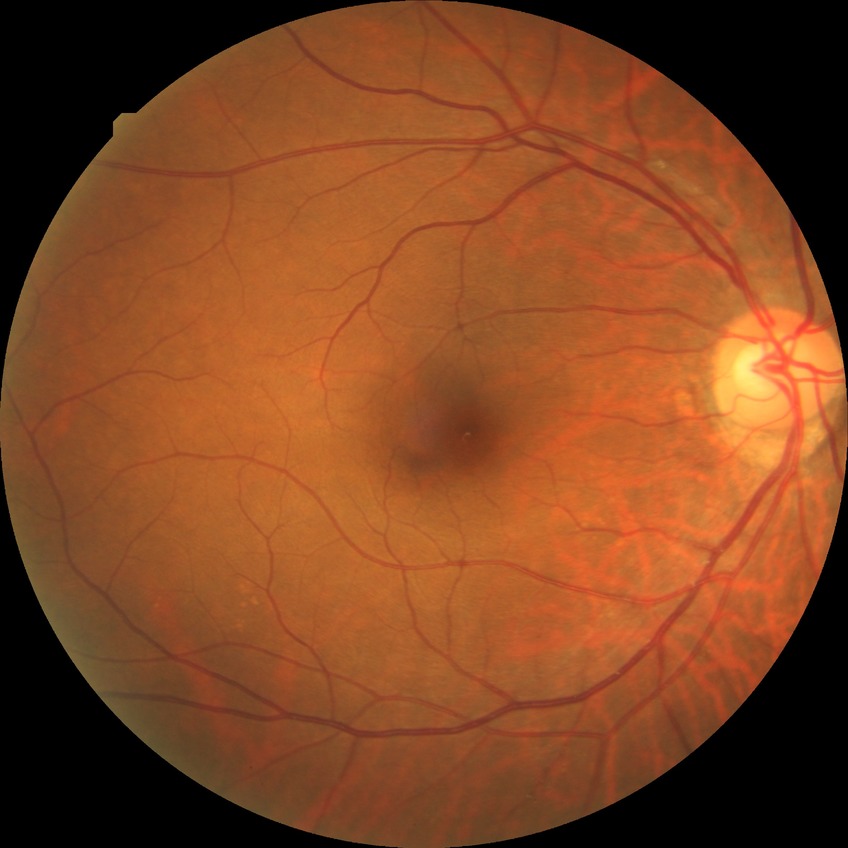 DR stage is NDR.